848x848, nonmydriatic, 45° FOV, DR severity per modified Davis staging — 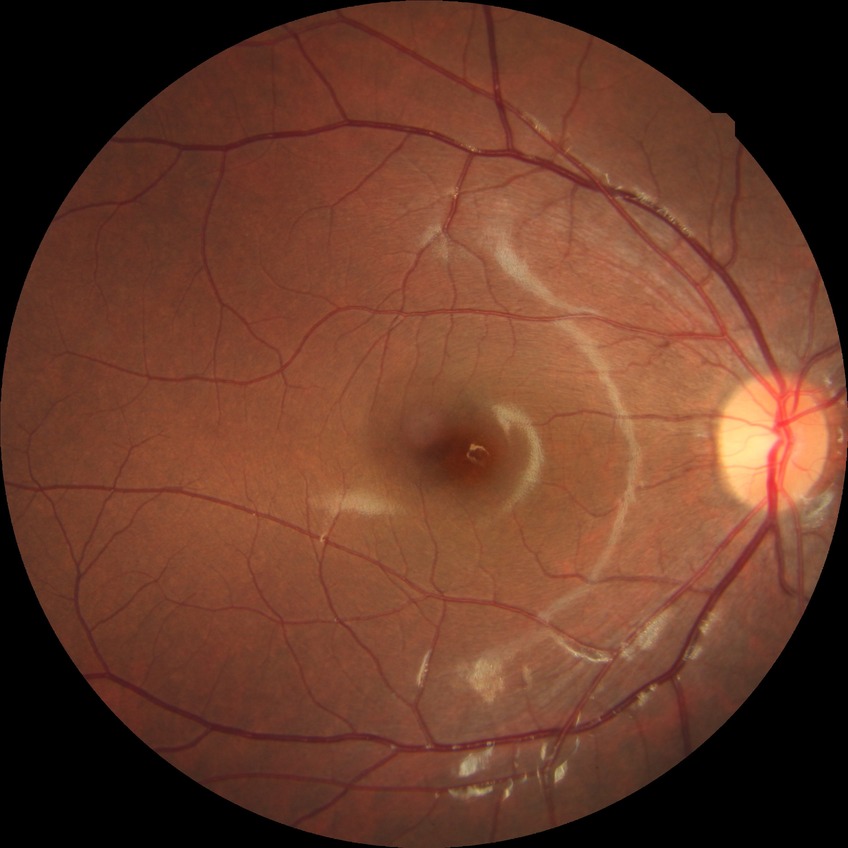 Retinopathy stage is no diabetic retinopathy.